2352x1568:
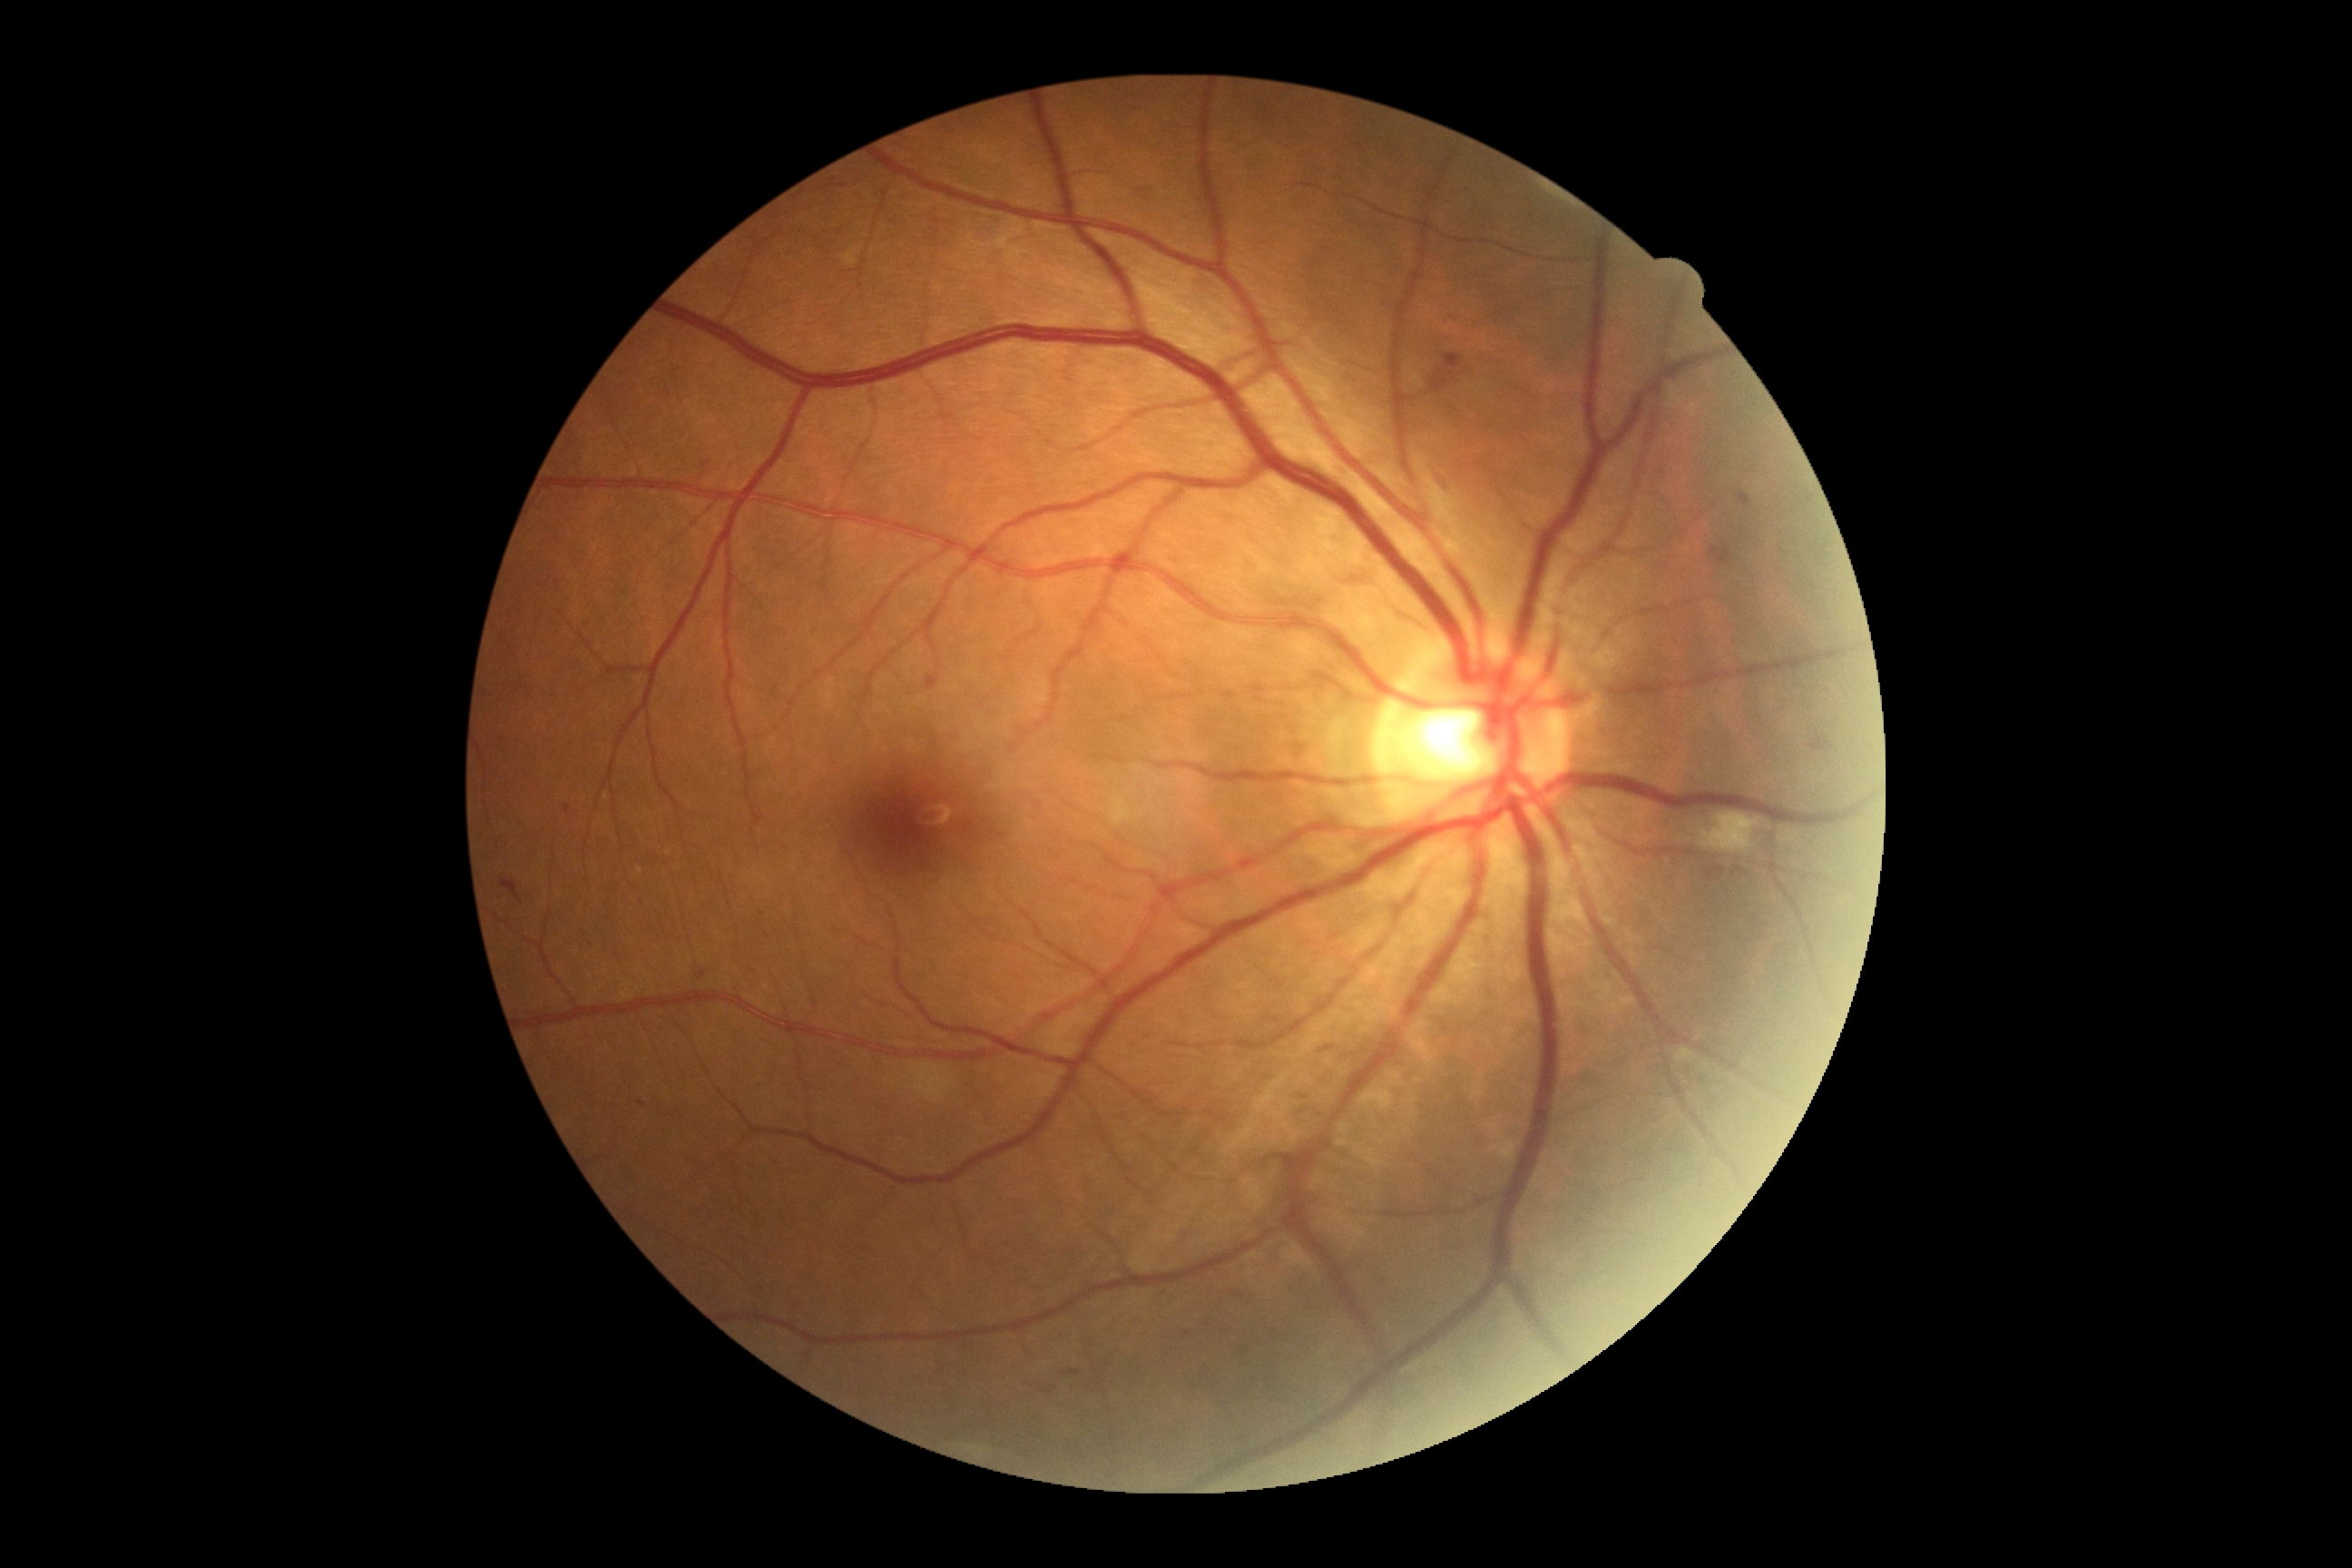

DR stage: 2/4.